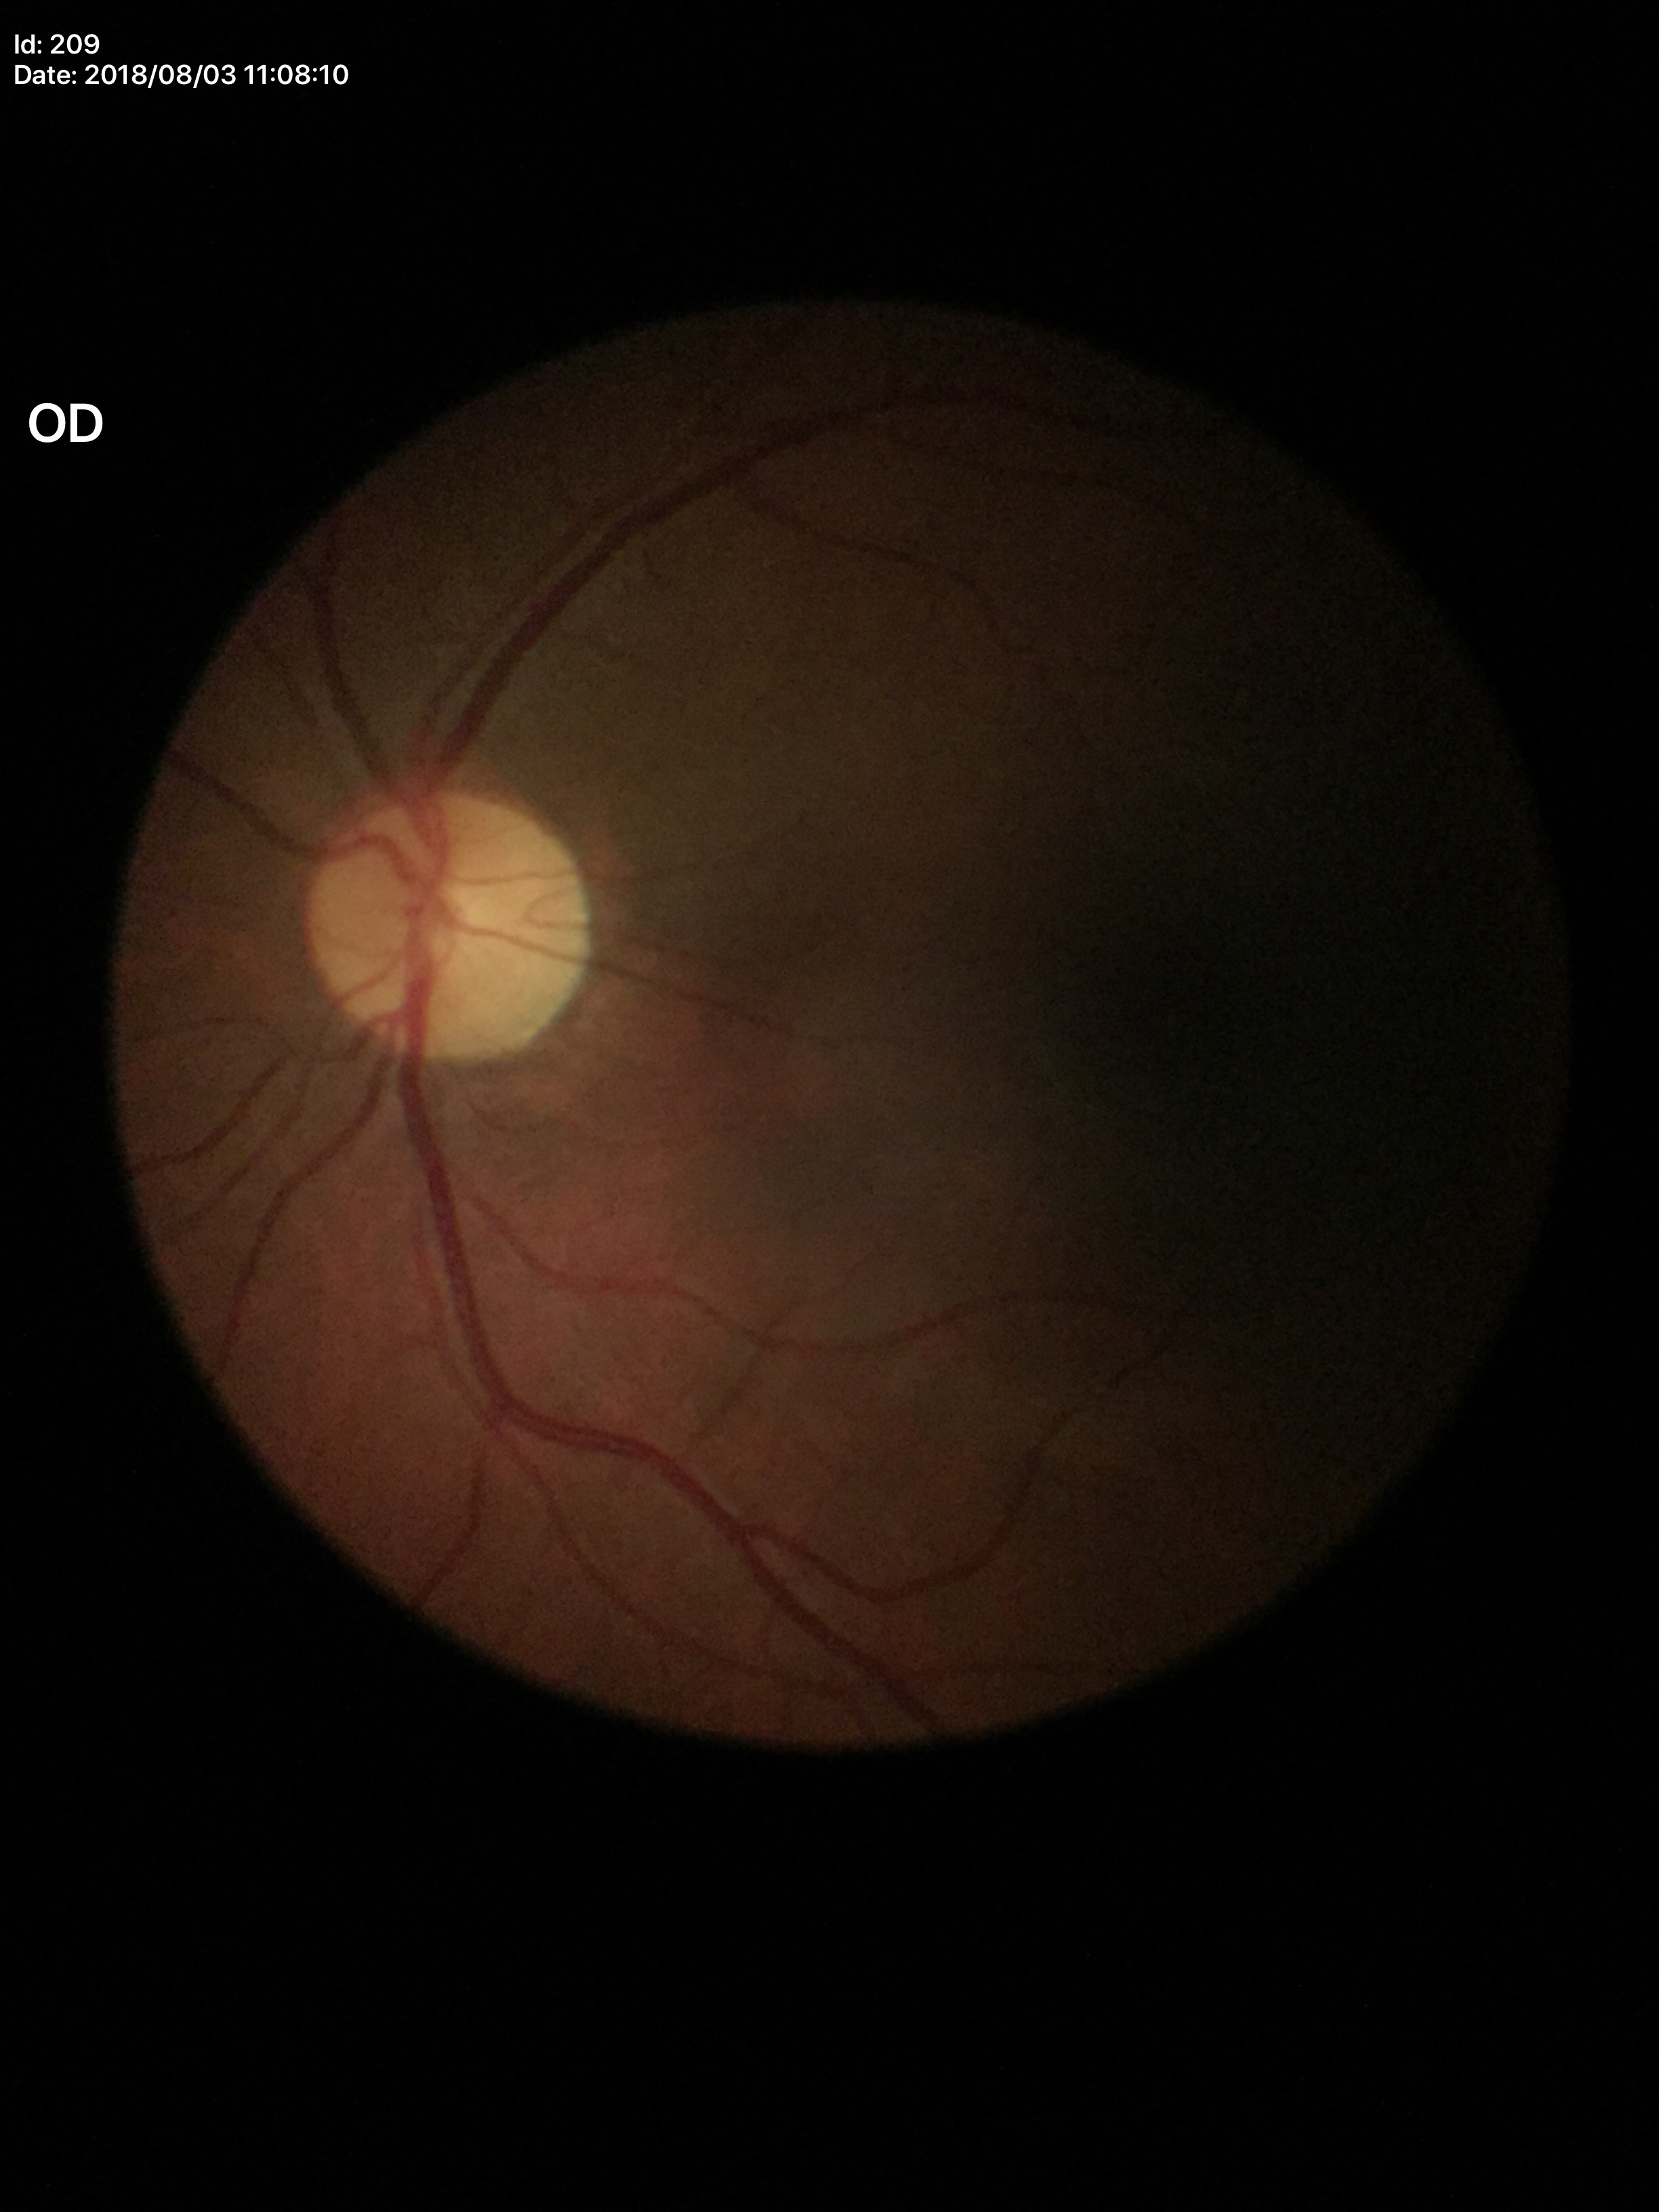
Glaucoma assessment = no suspicious findings
VCDR = 0.42